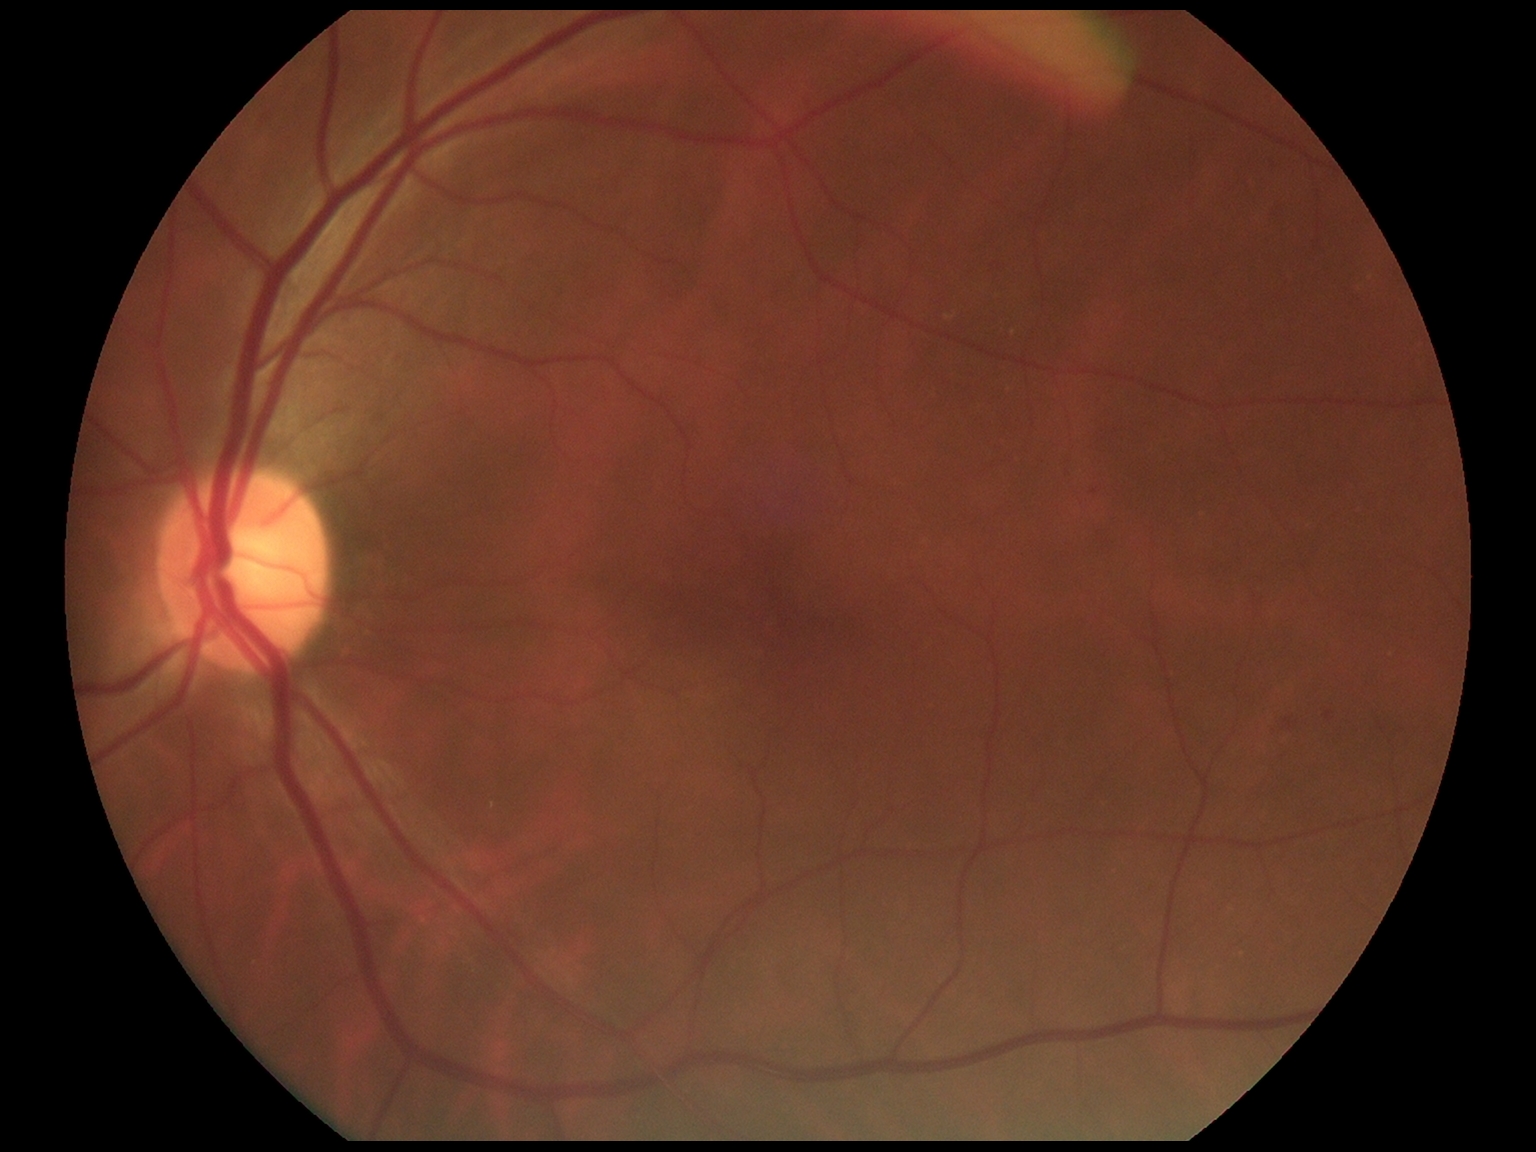

DR: 2.